45-degree field of view; 2212 x 1659 pixels — 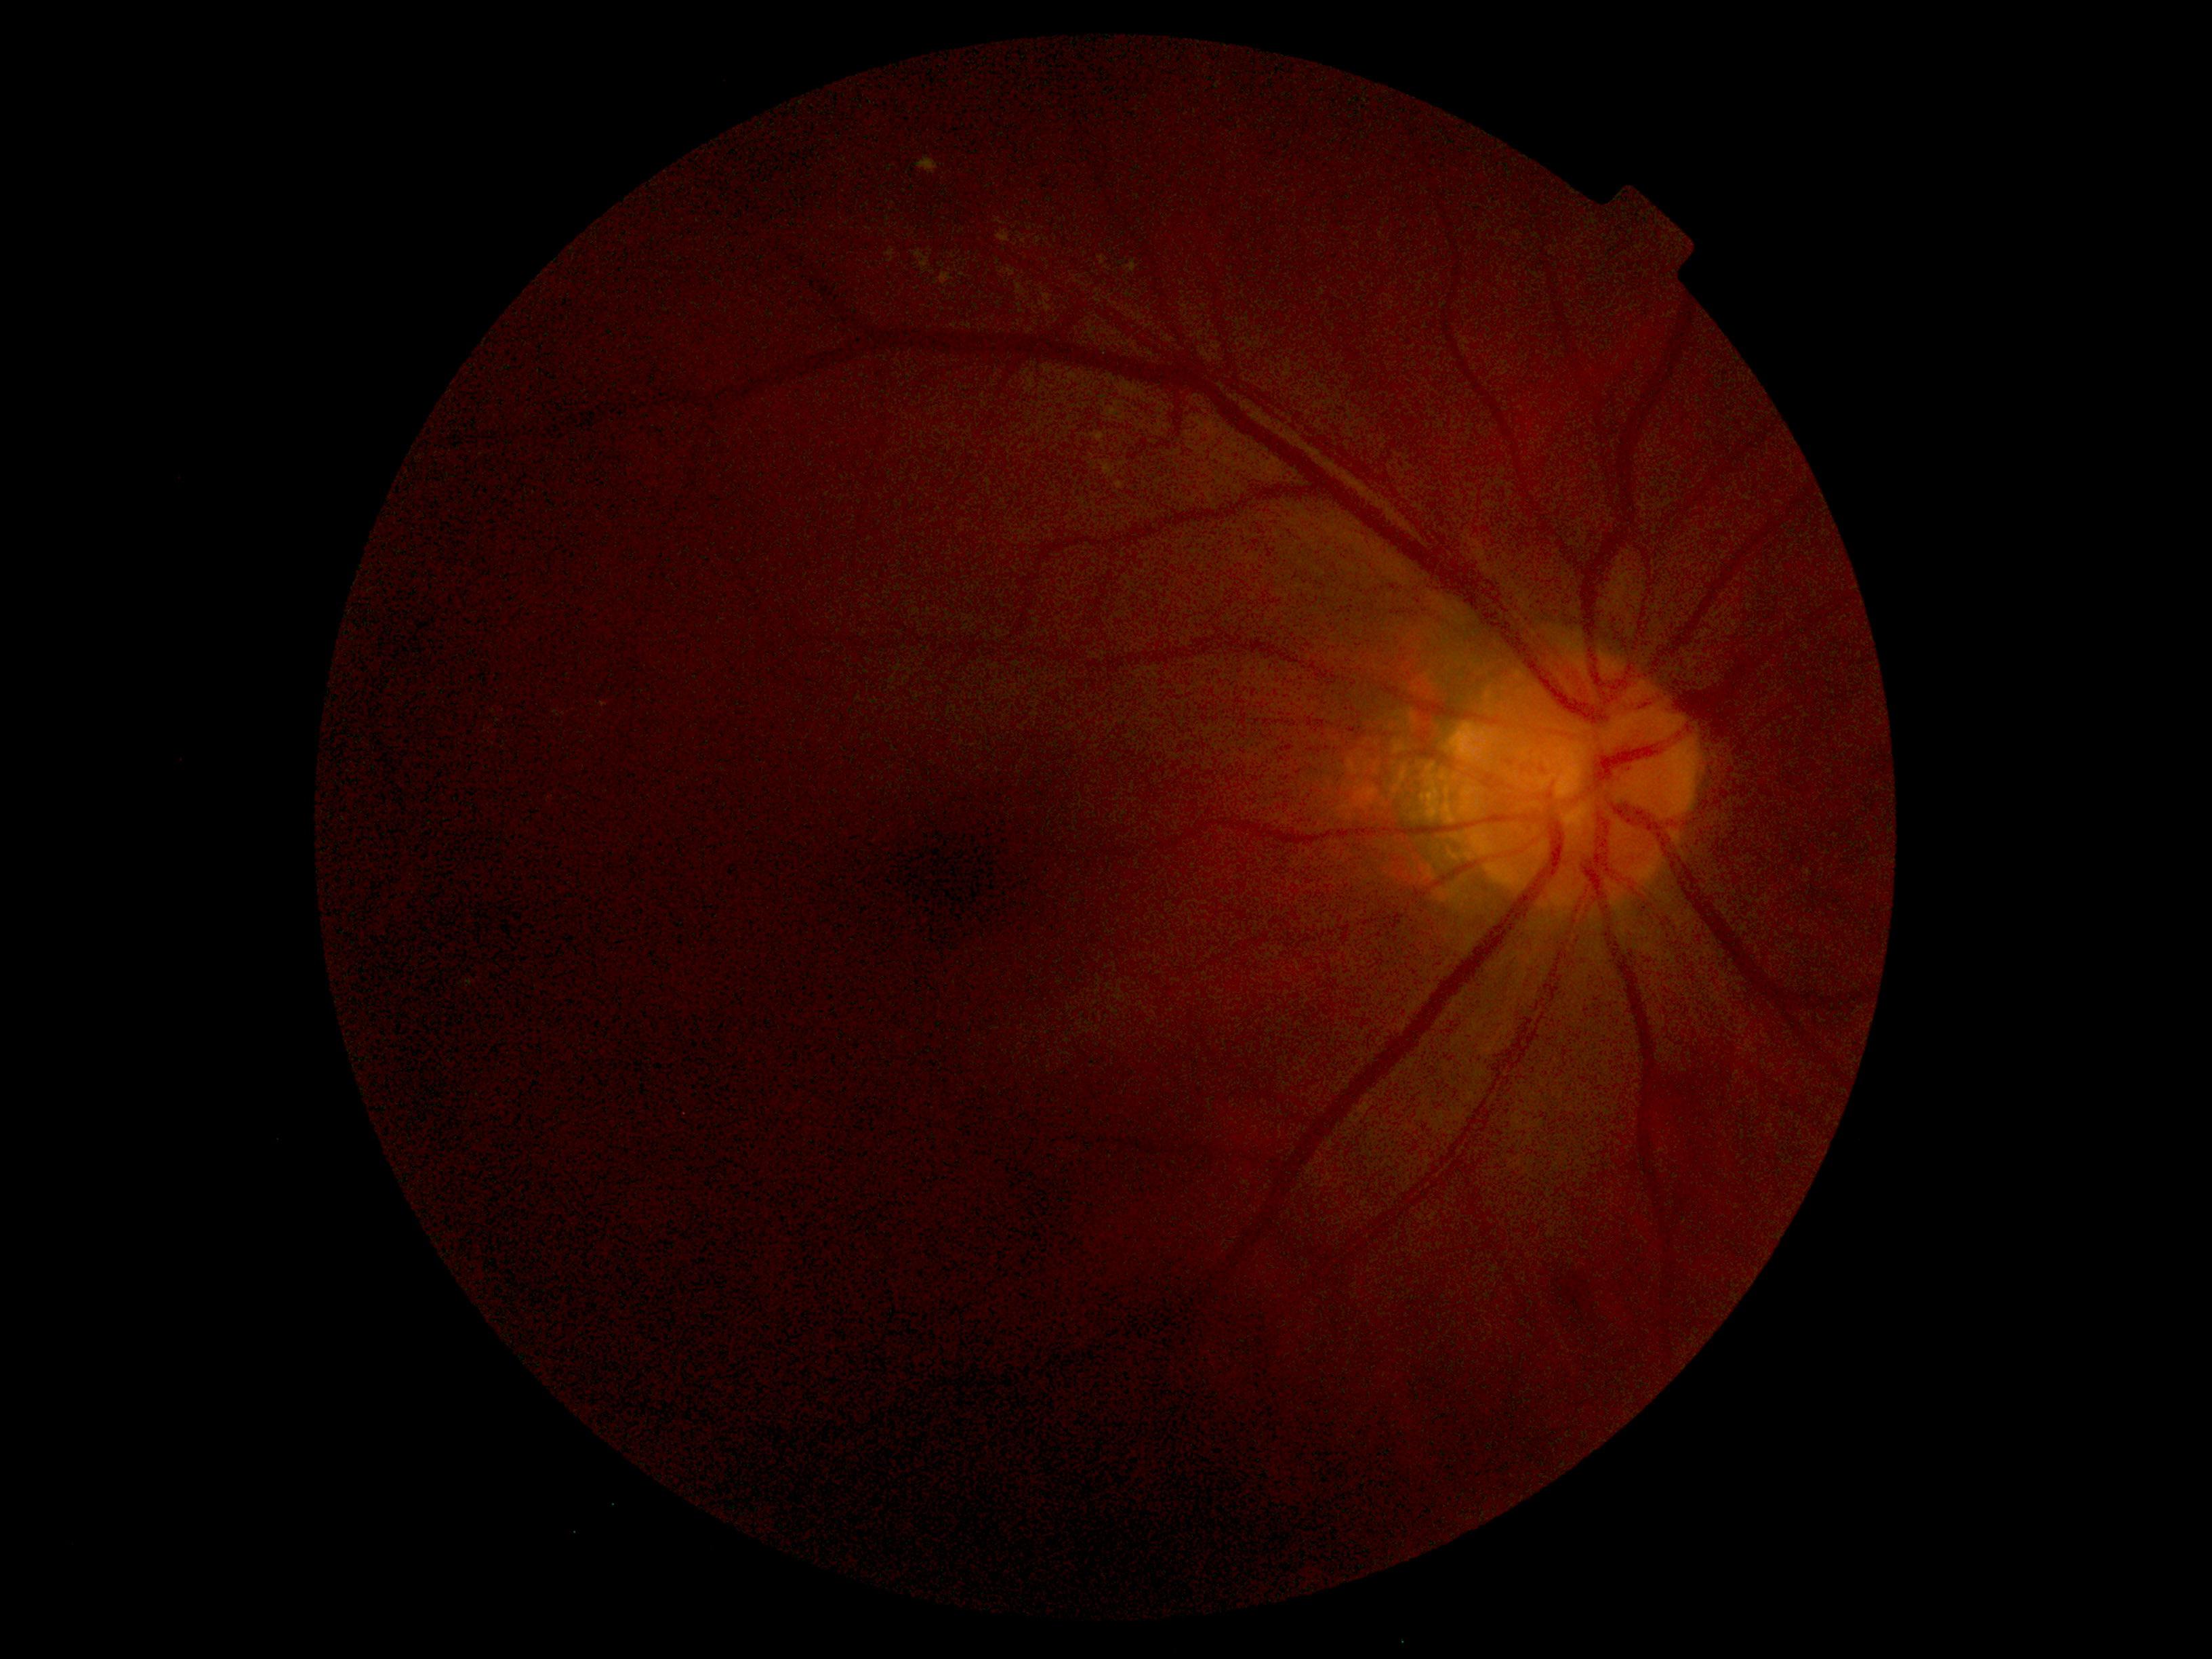 Diabetic retinopathy (DR): grade 2 (moderate NPDR).